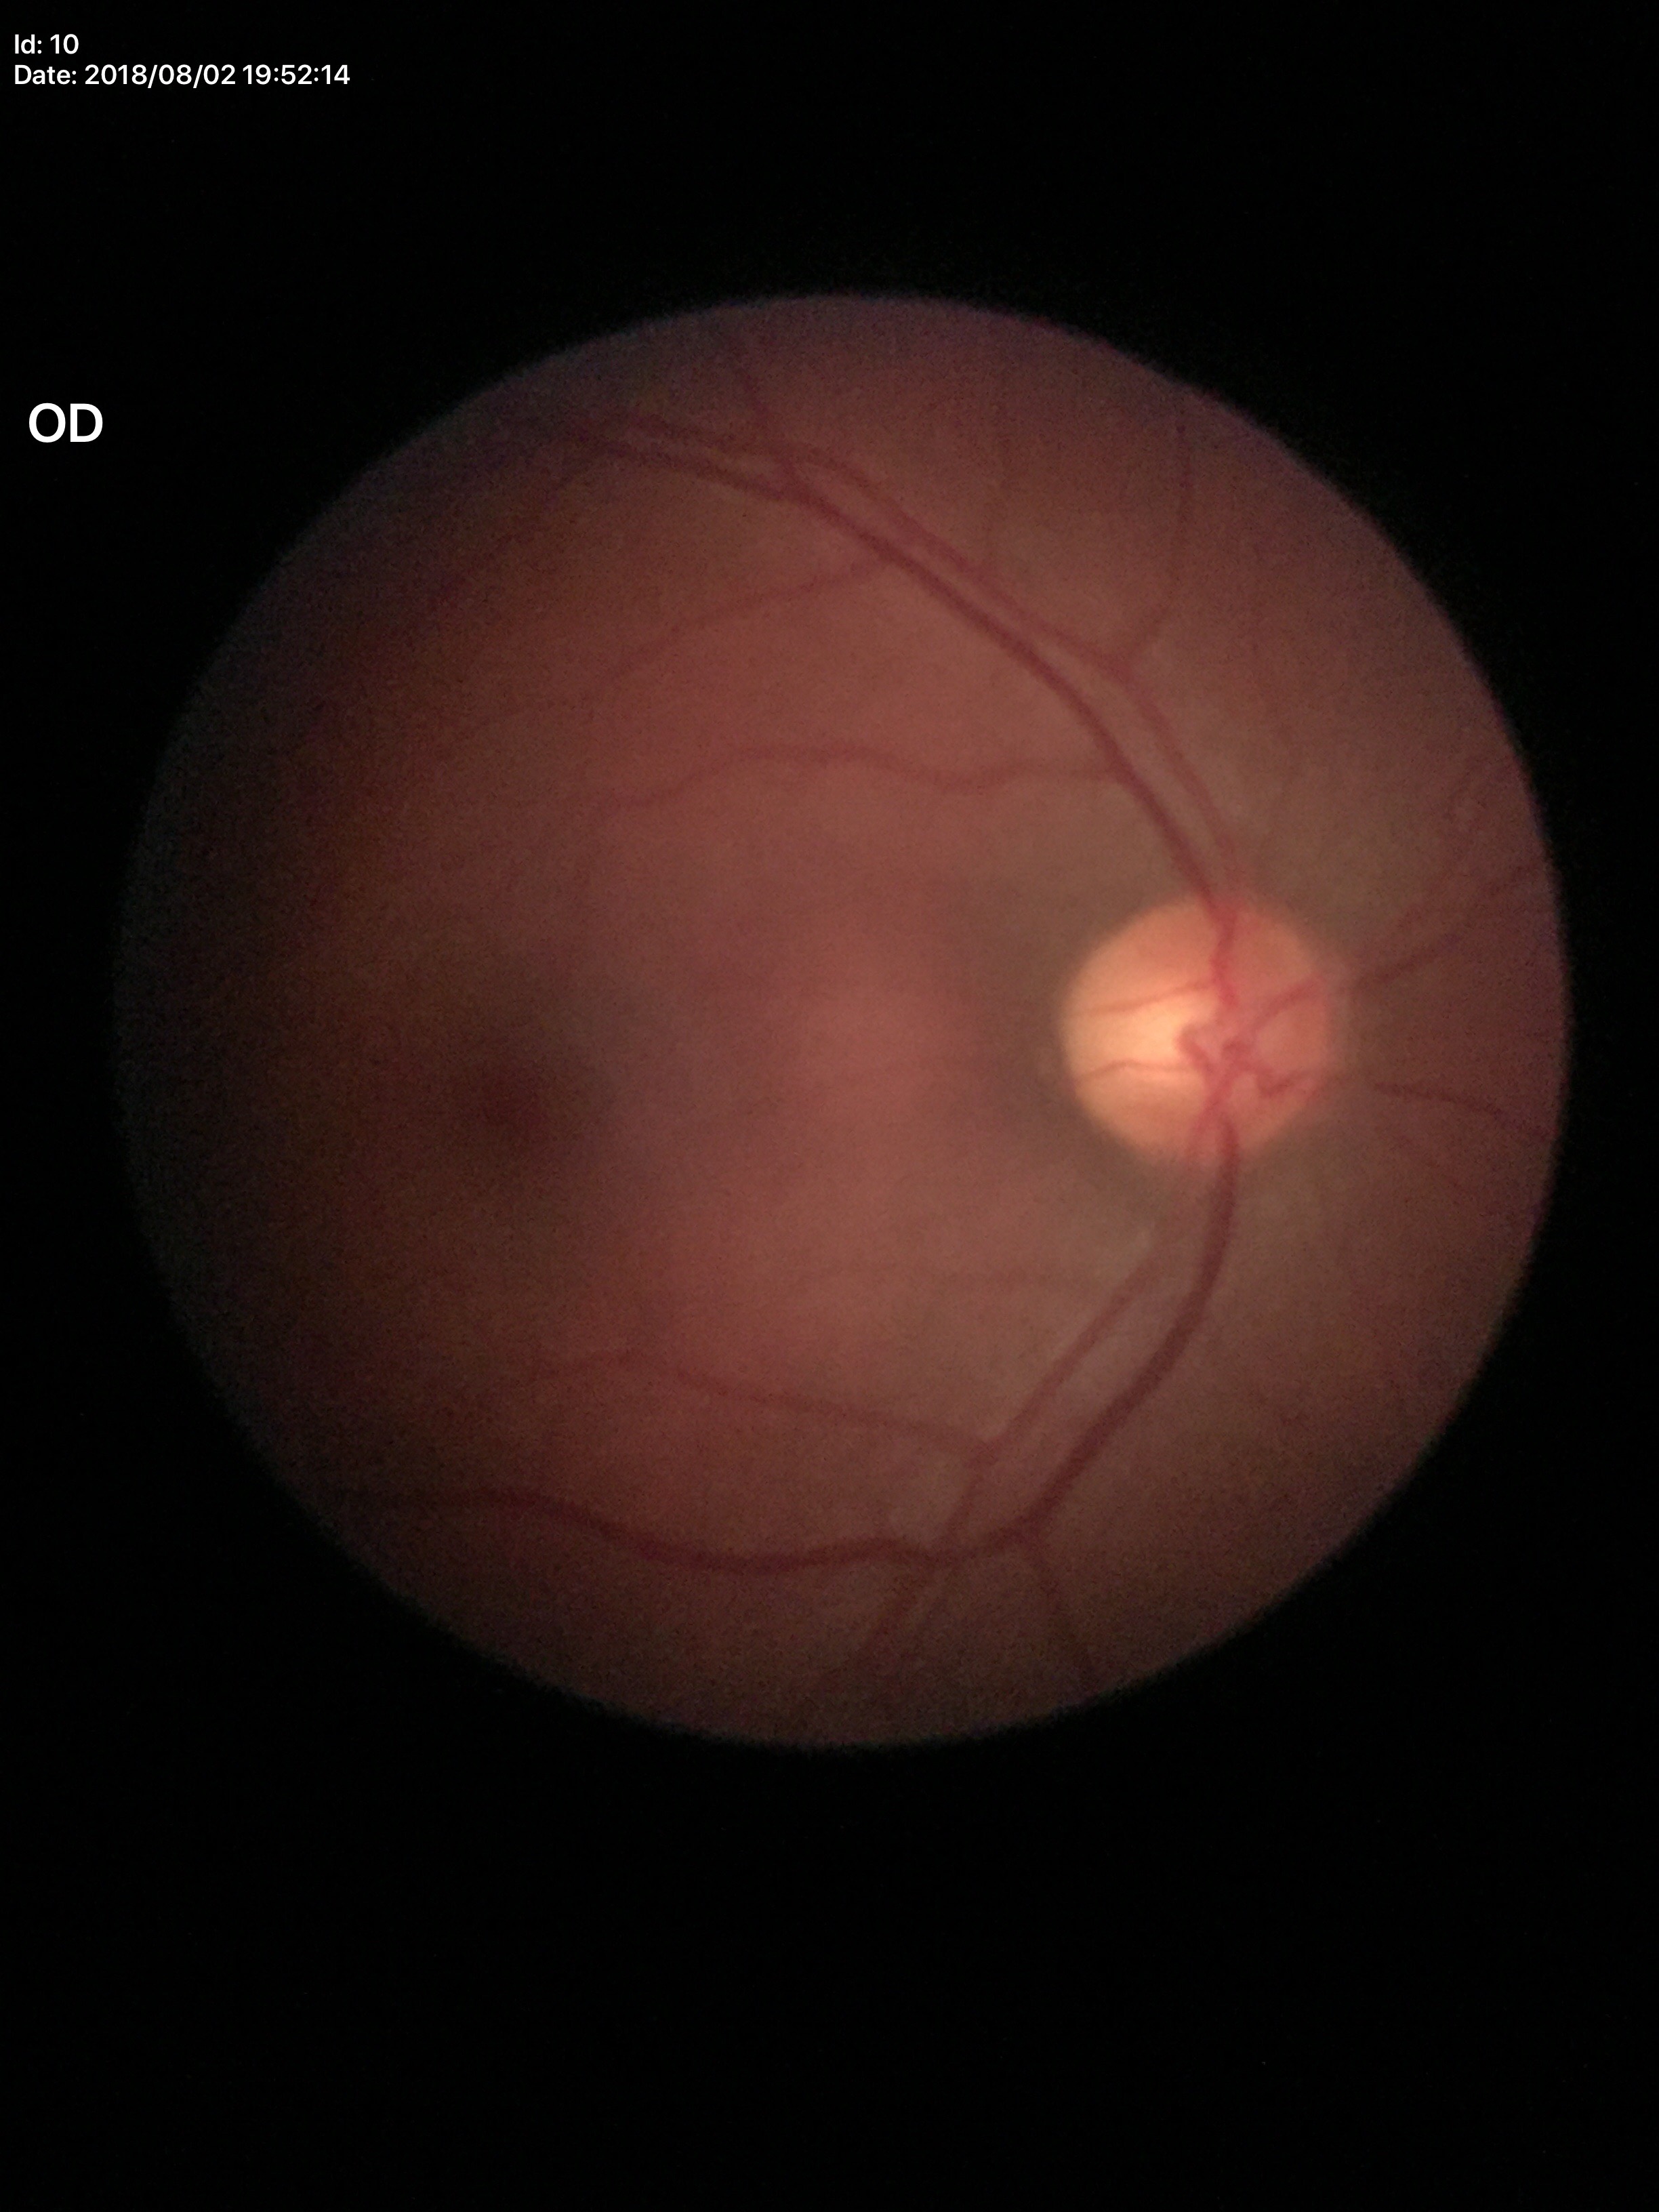 Q: Glaucoma screening result?
A: negative
Q: What is the vertical cup-to-disc ratio?
A: 0.53